Captured after pupil dilation · macula-centered field: 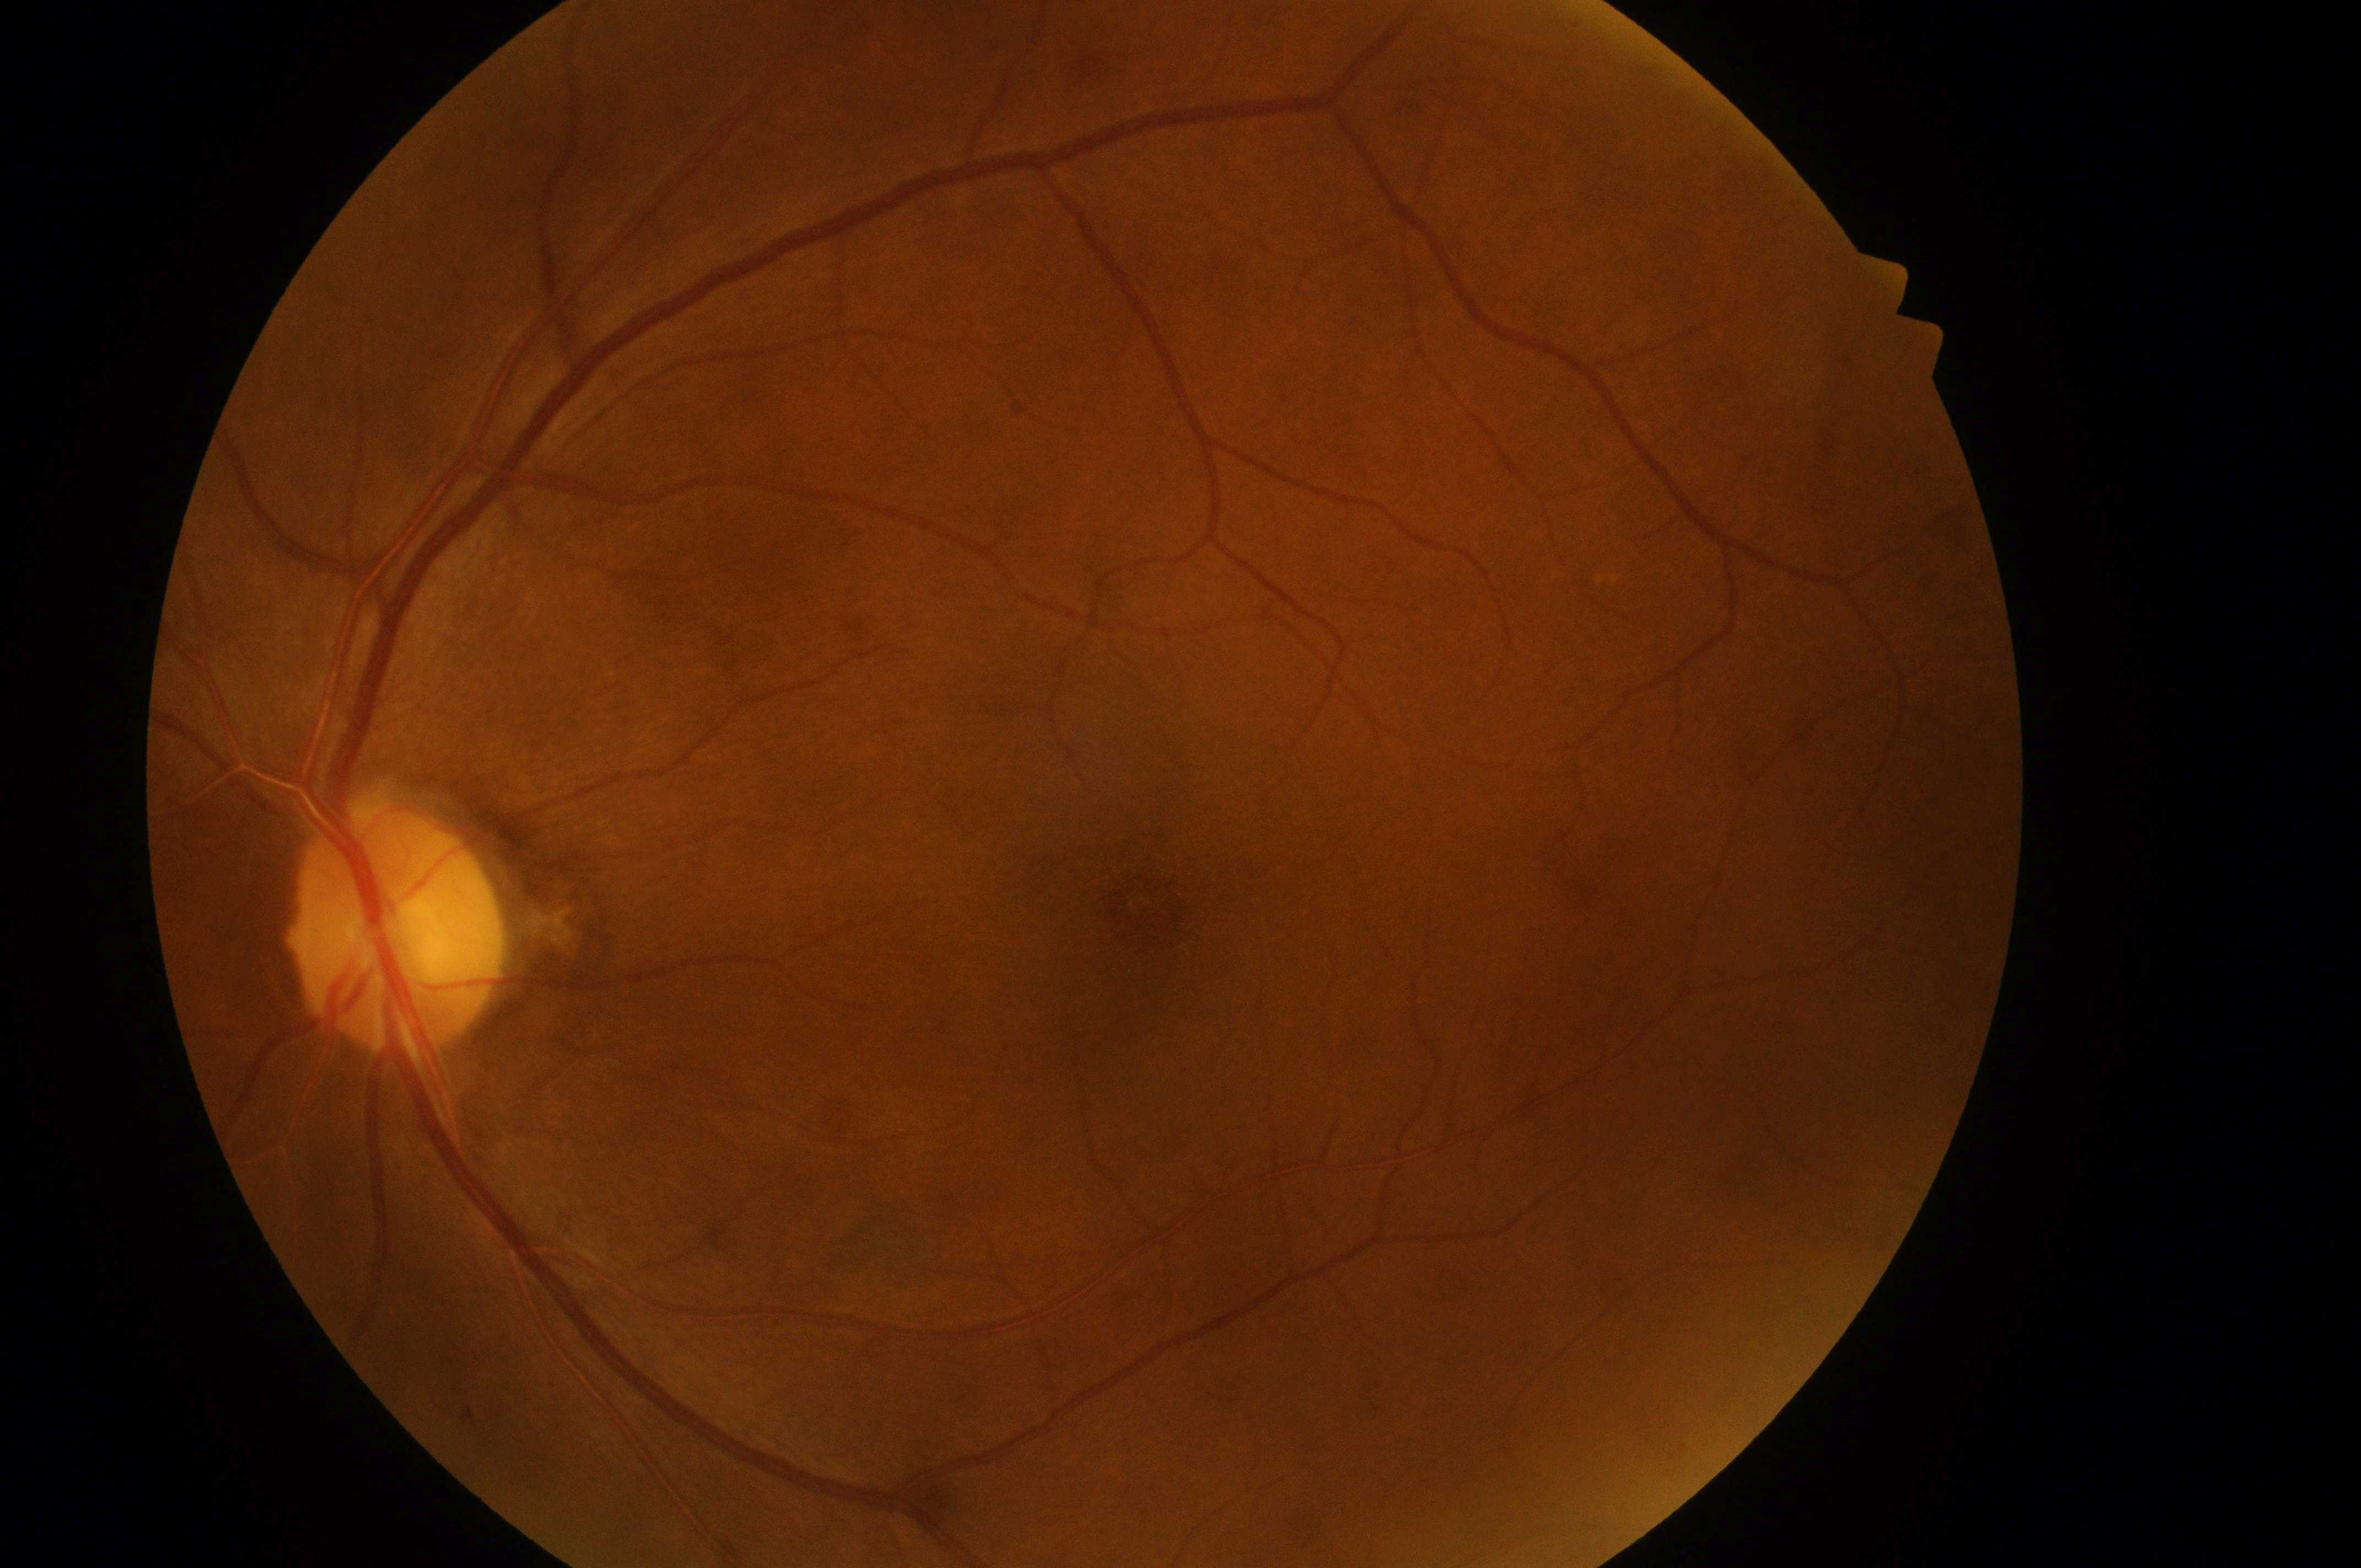
{"dme_grade": "0 (no risk)", "optic_disc": "x=391, y=940", "fovea": "x=1149, y=913", "dr_grade": "no apparent diabetic retinopathy (grade 0)", "eye": "left eye", "dr_impression": "No diabetic retinopathy; no macular edema risk"}